Color fundus image · 848 by 848 pixels: 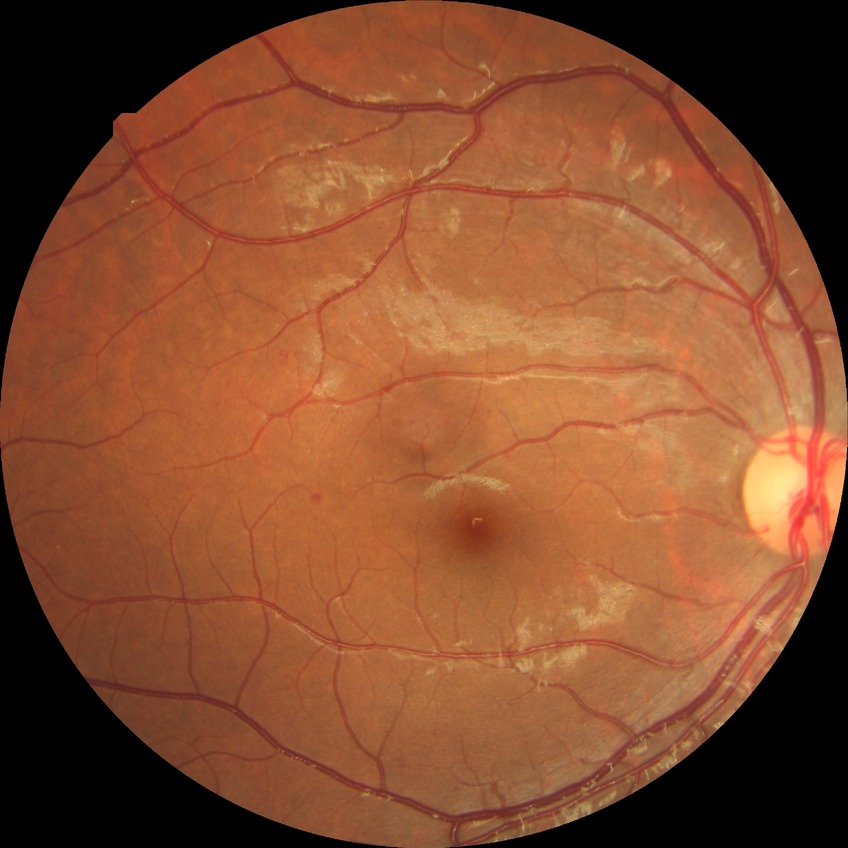 Diabetic retinopathy (DR): simple diabetic retinopathy (SDR).